Without pupil dilation, modified Davis classification, NIDEK AFC-230 fundus camera:
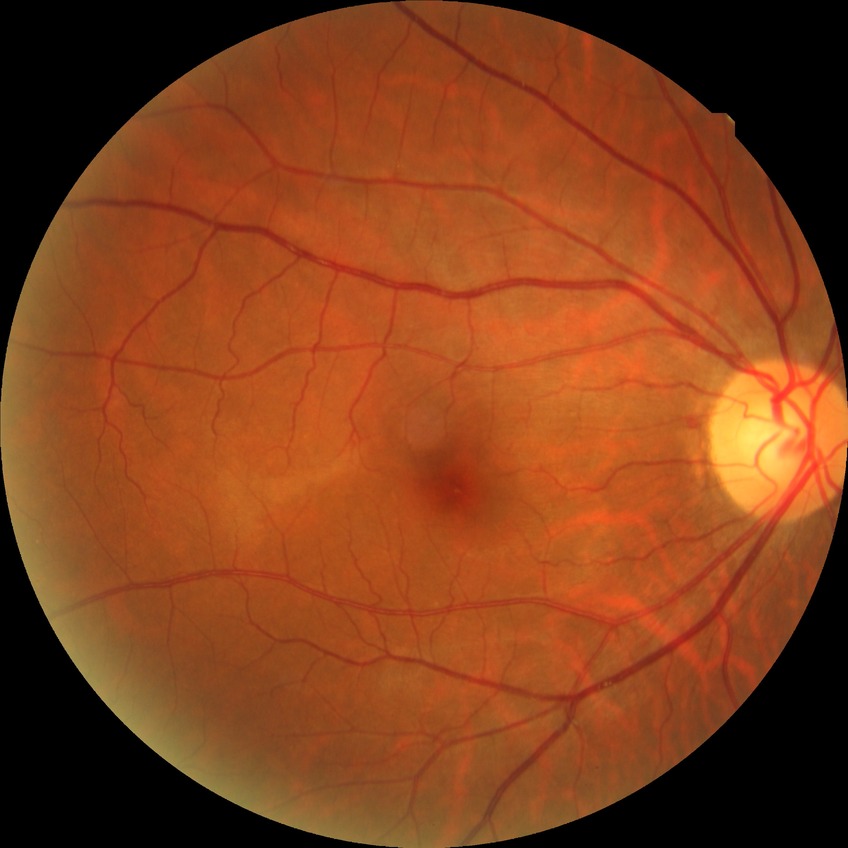

modified Davis grading = simple diabetic retinopathy